Image size 1440x1080 · pediatric wide-field fundus photograph
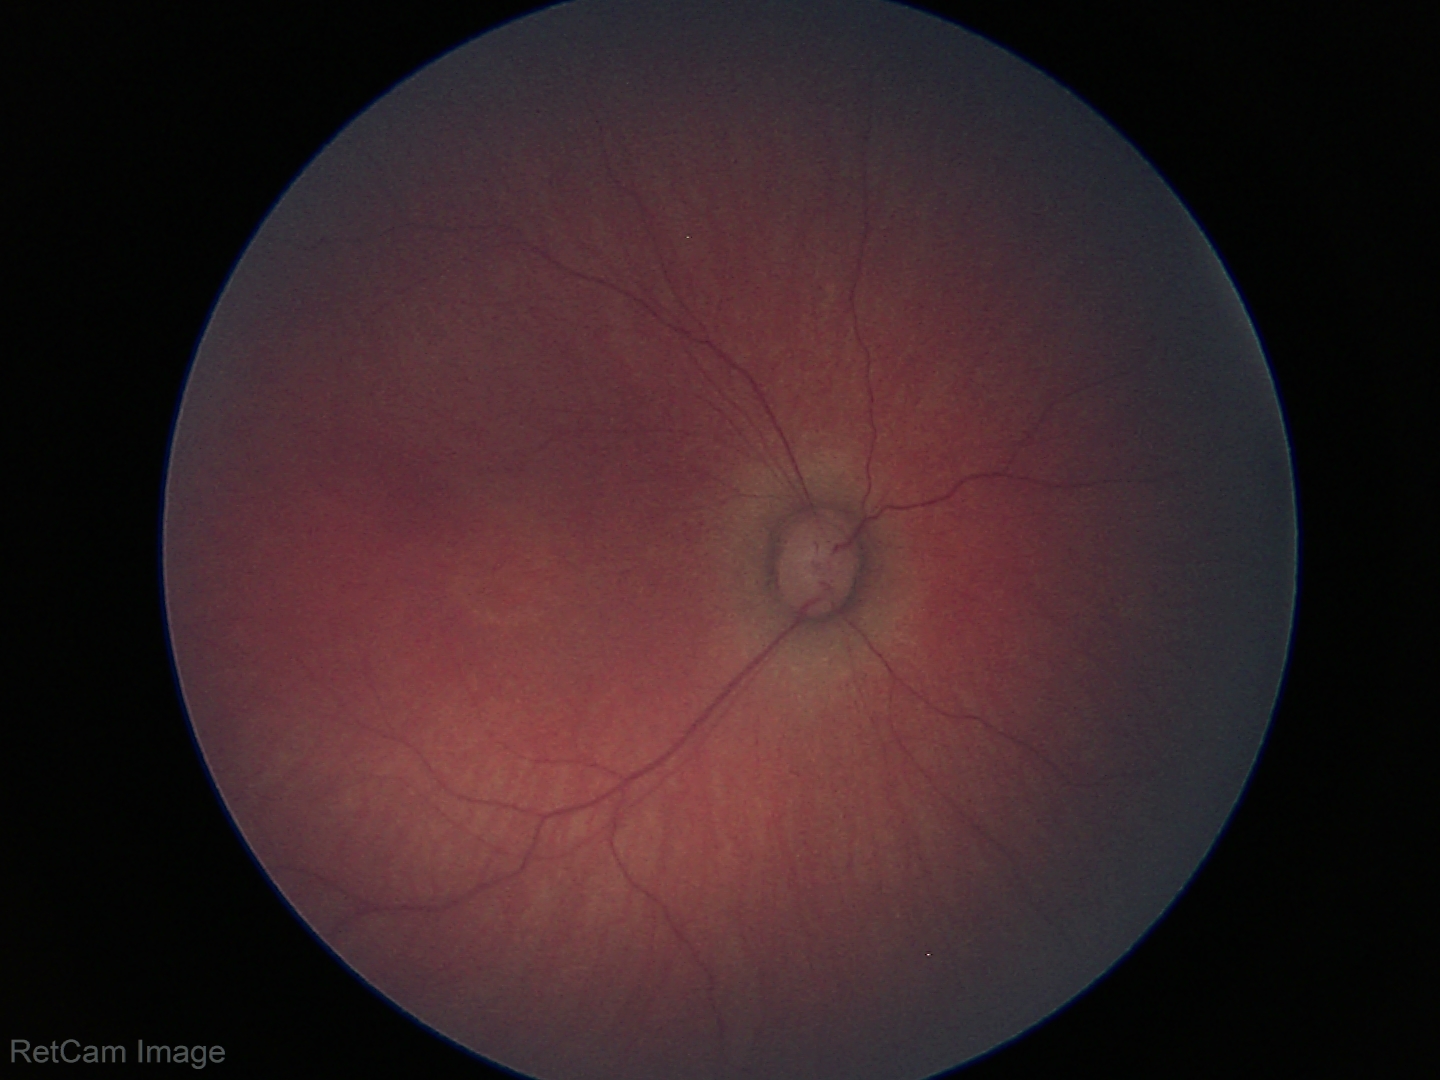
Screening examination with no abnormal retinal findings.